Nonmydriatic
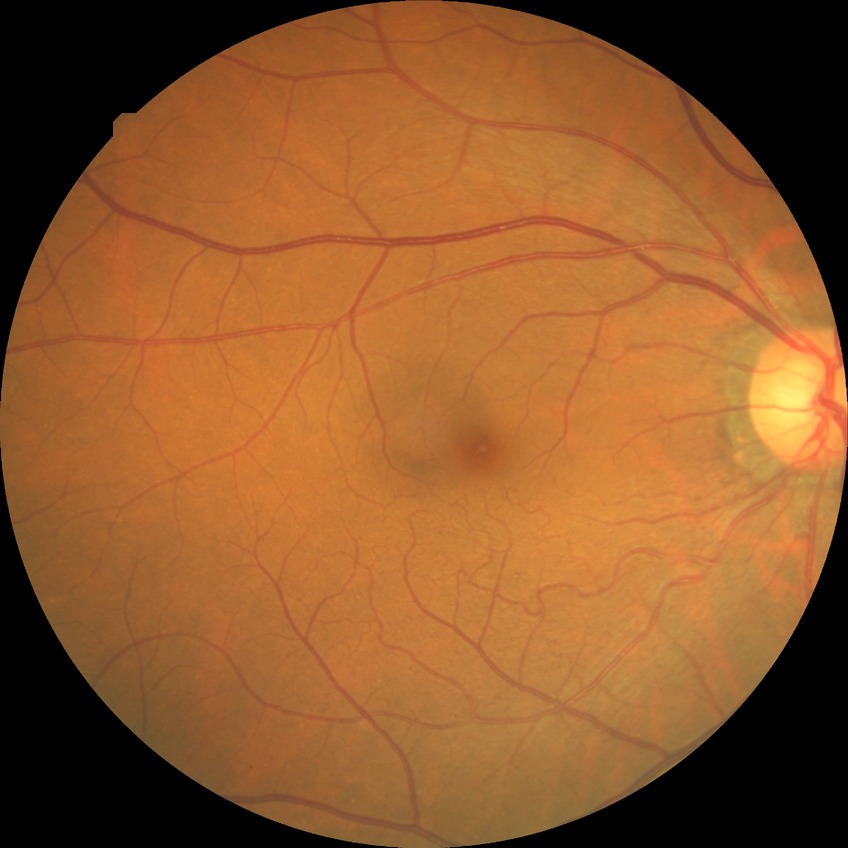
Modified Davis grading is no diabetic retinopathy.